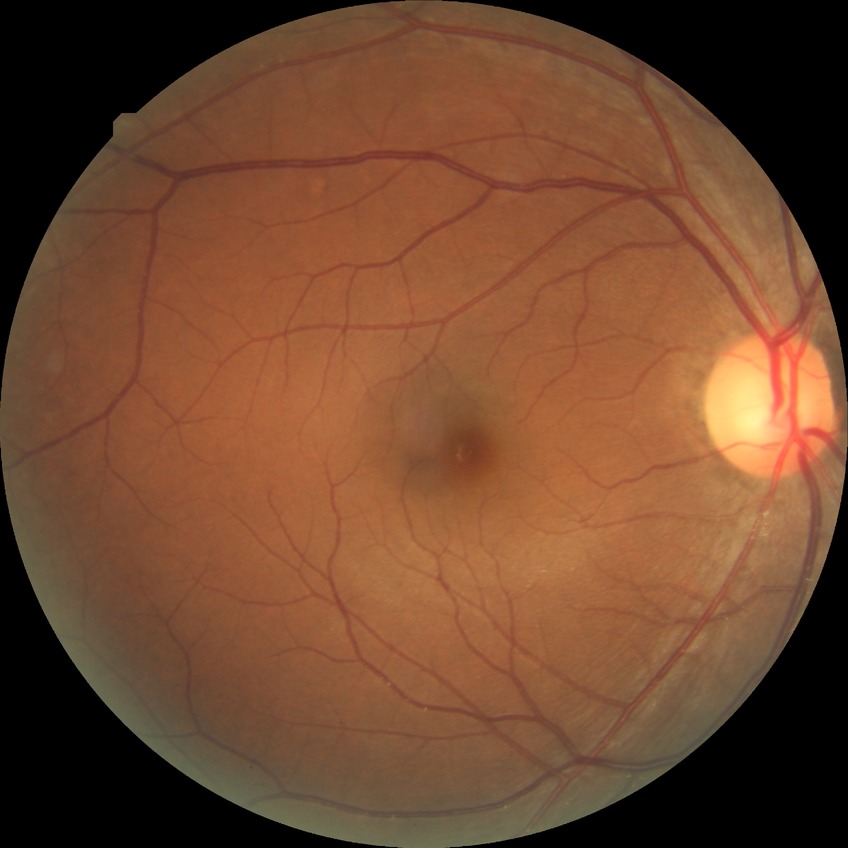 Diabetic retinopathy (DR): no diabetic retinopathy (NDR).